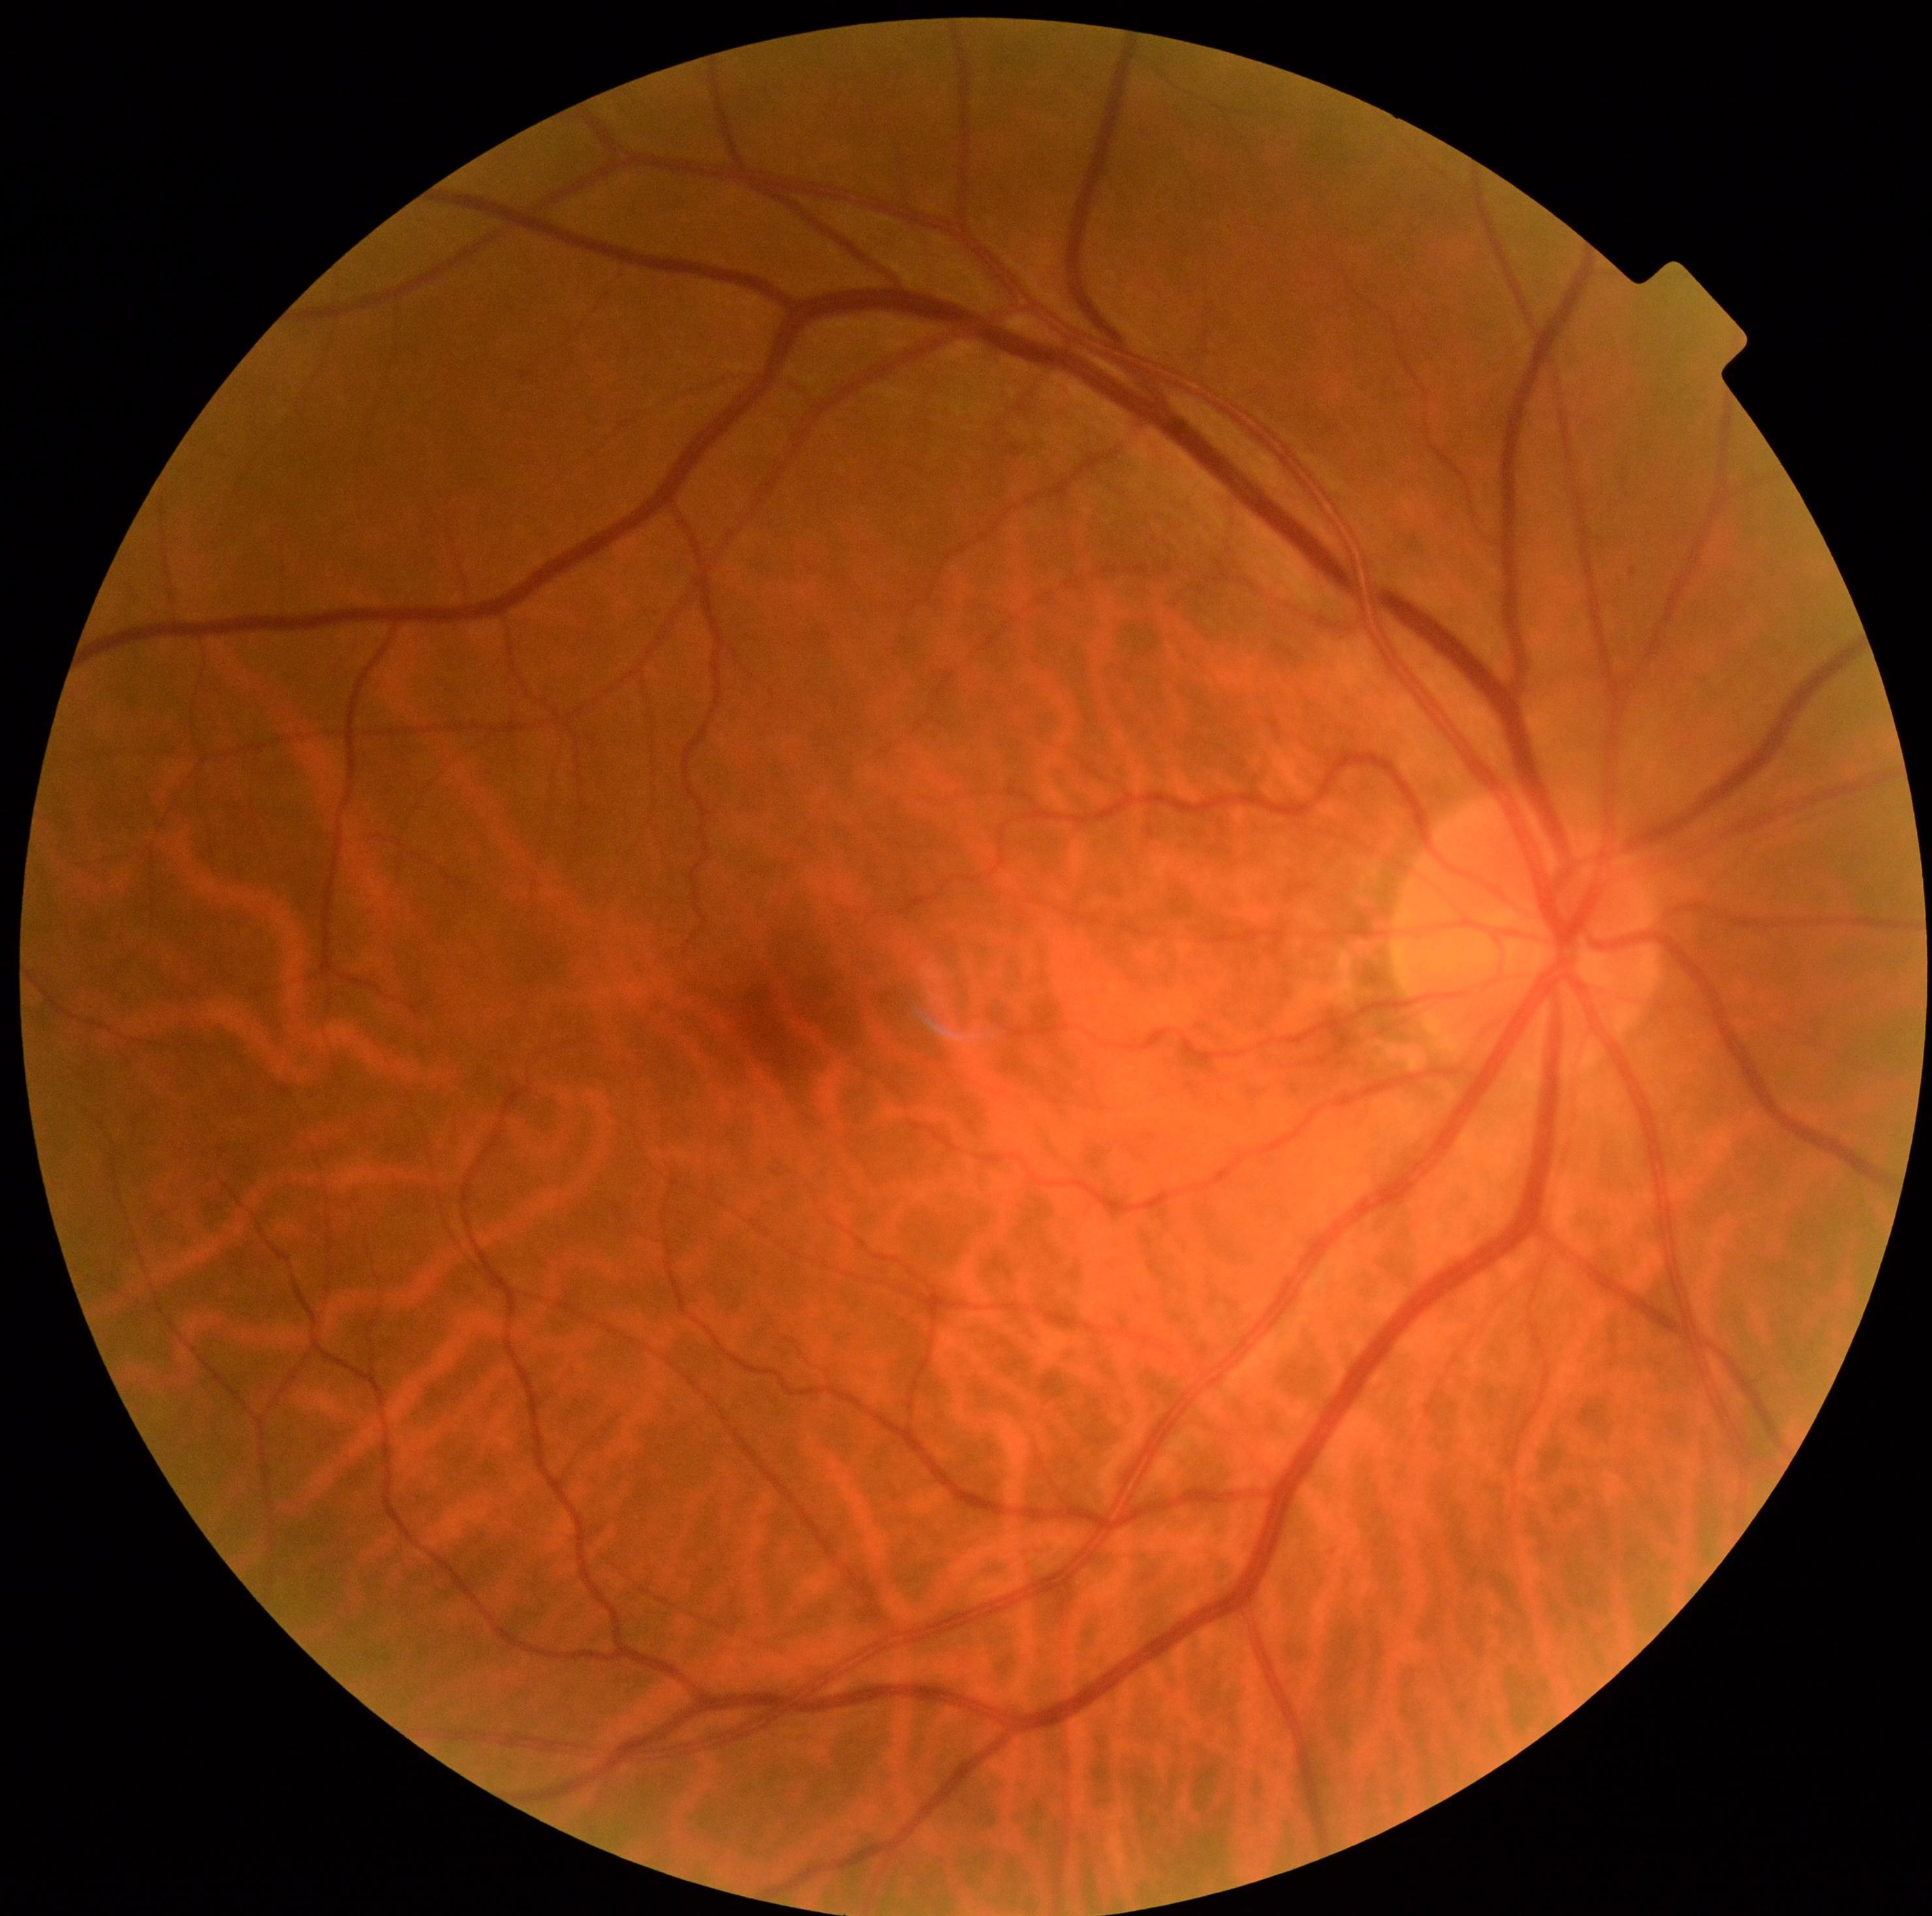 * DR severity — 0/4 — no visible signs of diabetic retinopathy